Nonmydriatic · retinal fundus photograph:
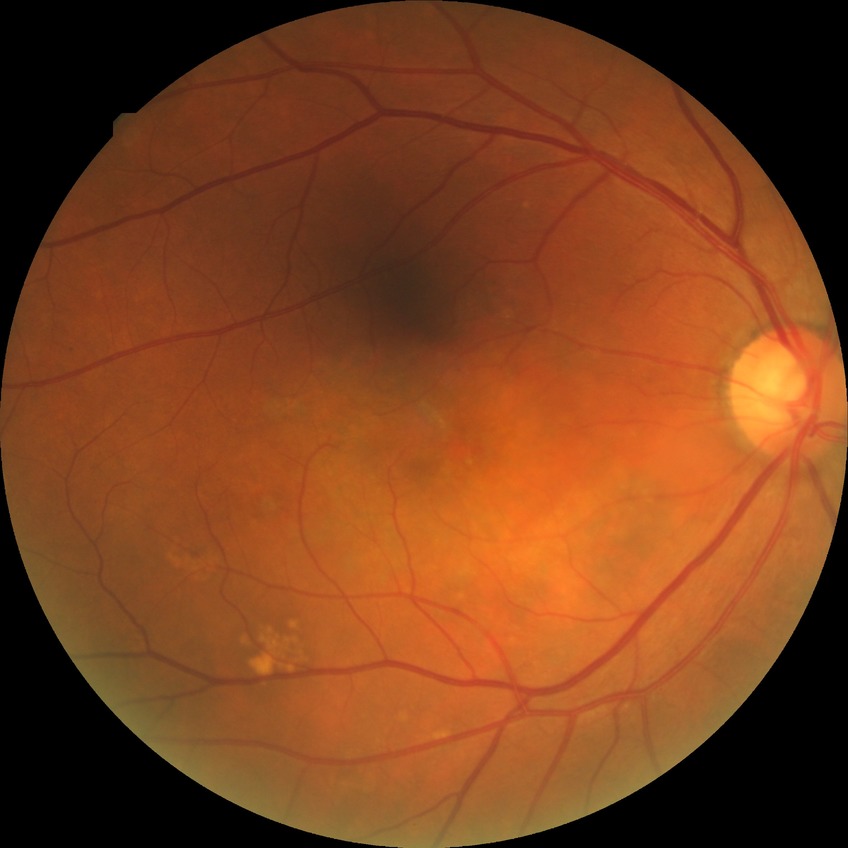
Diabetic retinopathy (DR): no diabetic retinopathy (NDR).